2352 x 1568 pixels:
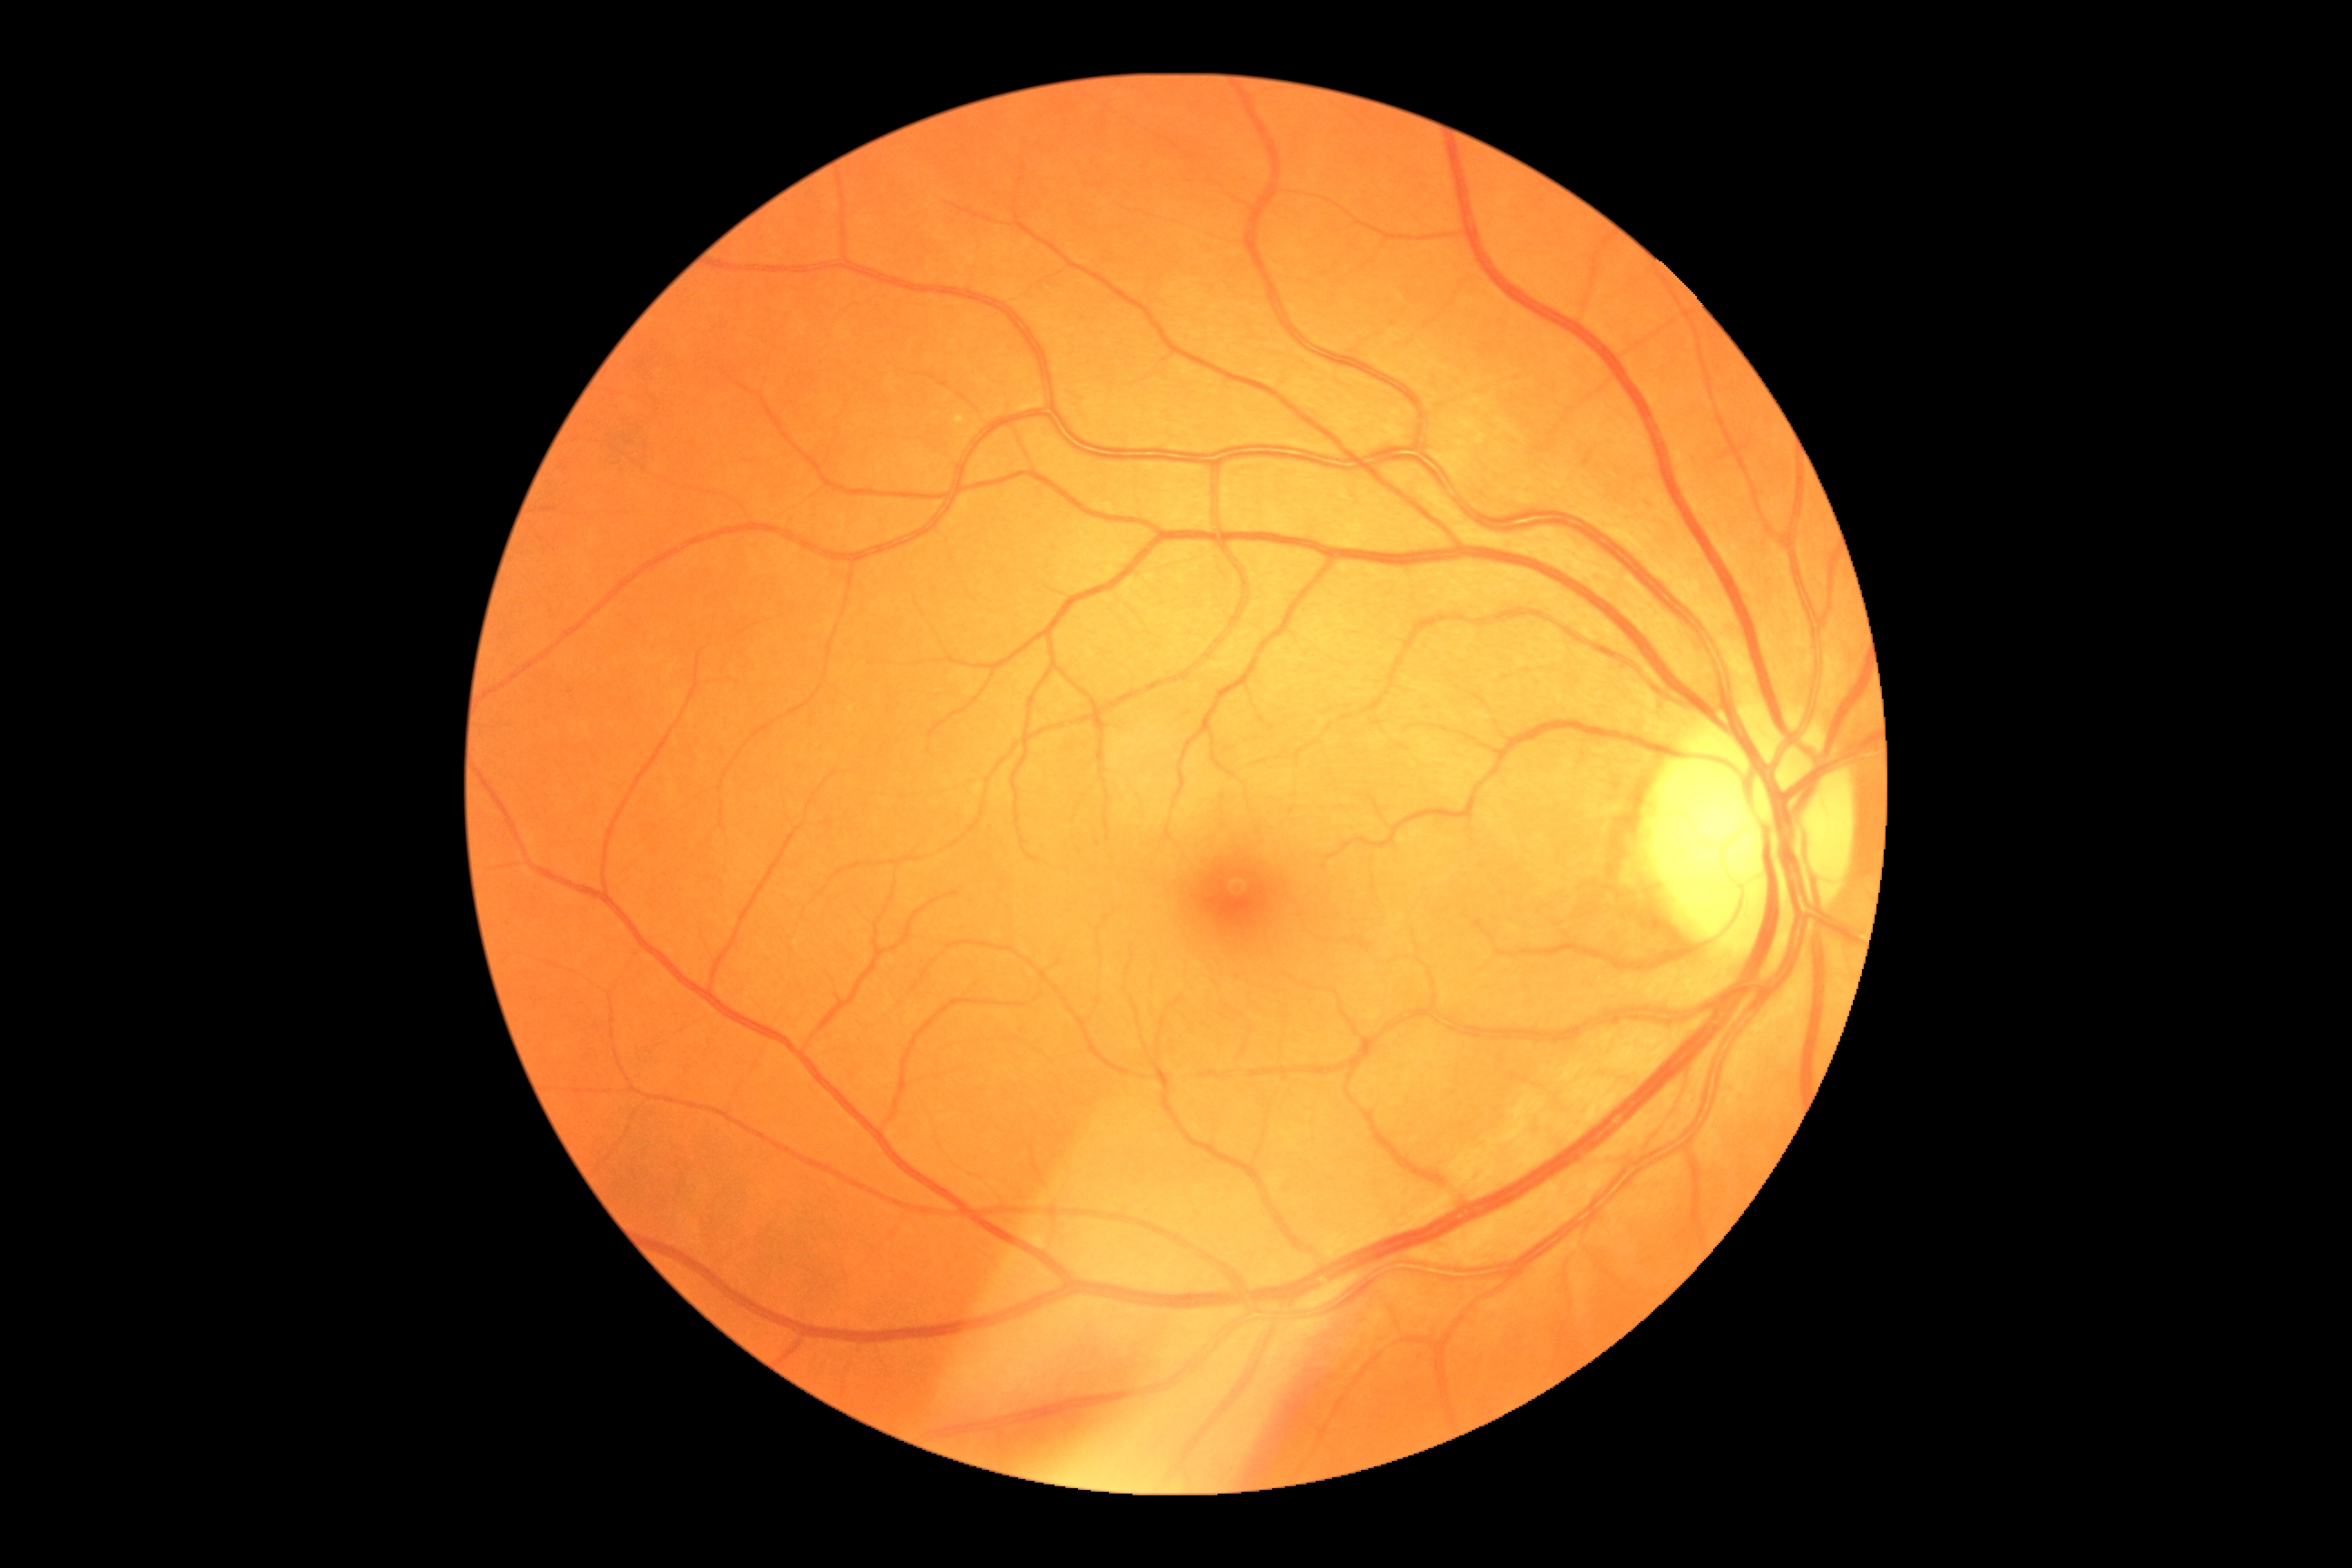
DR is 0/4.